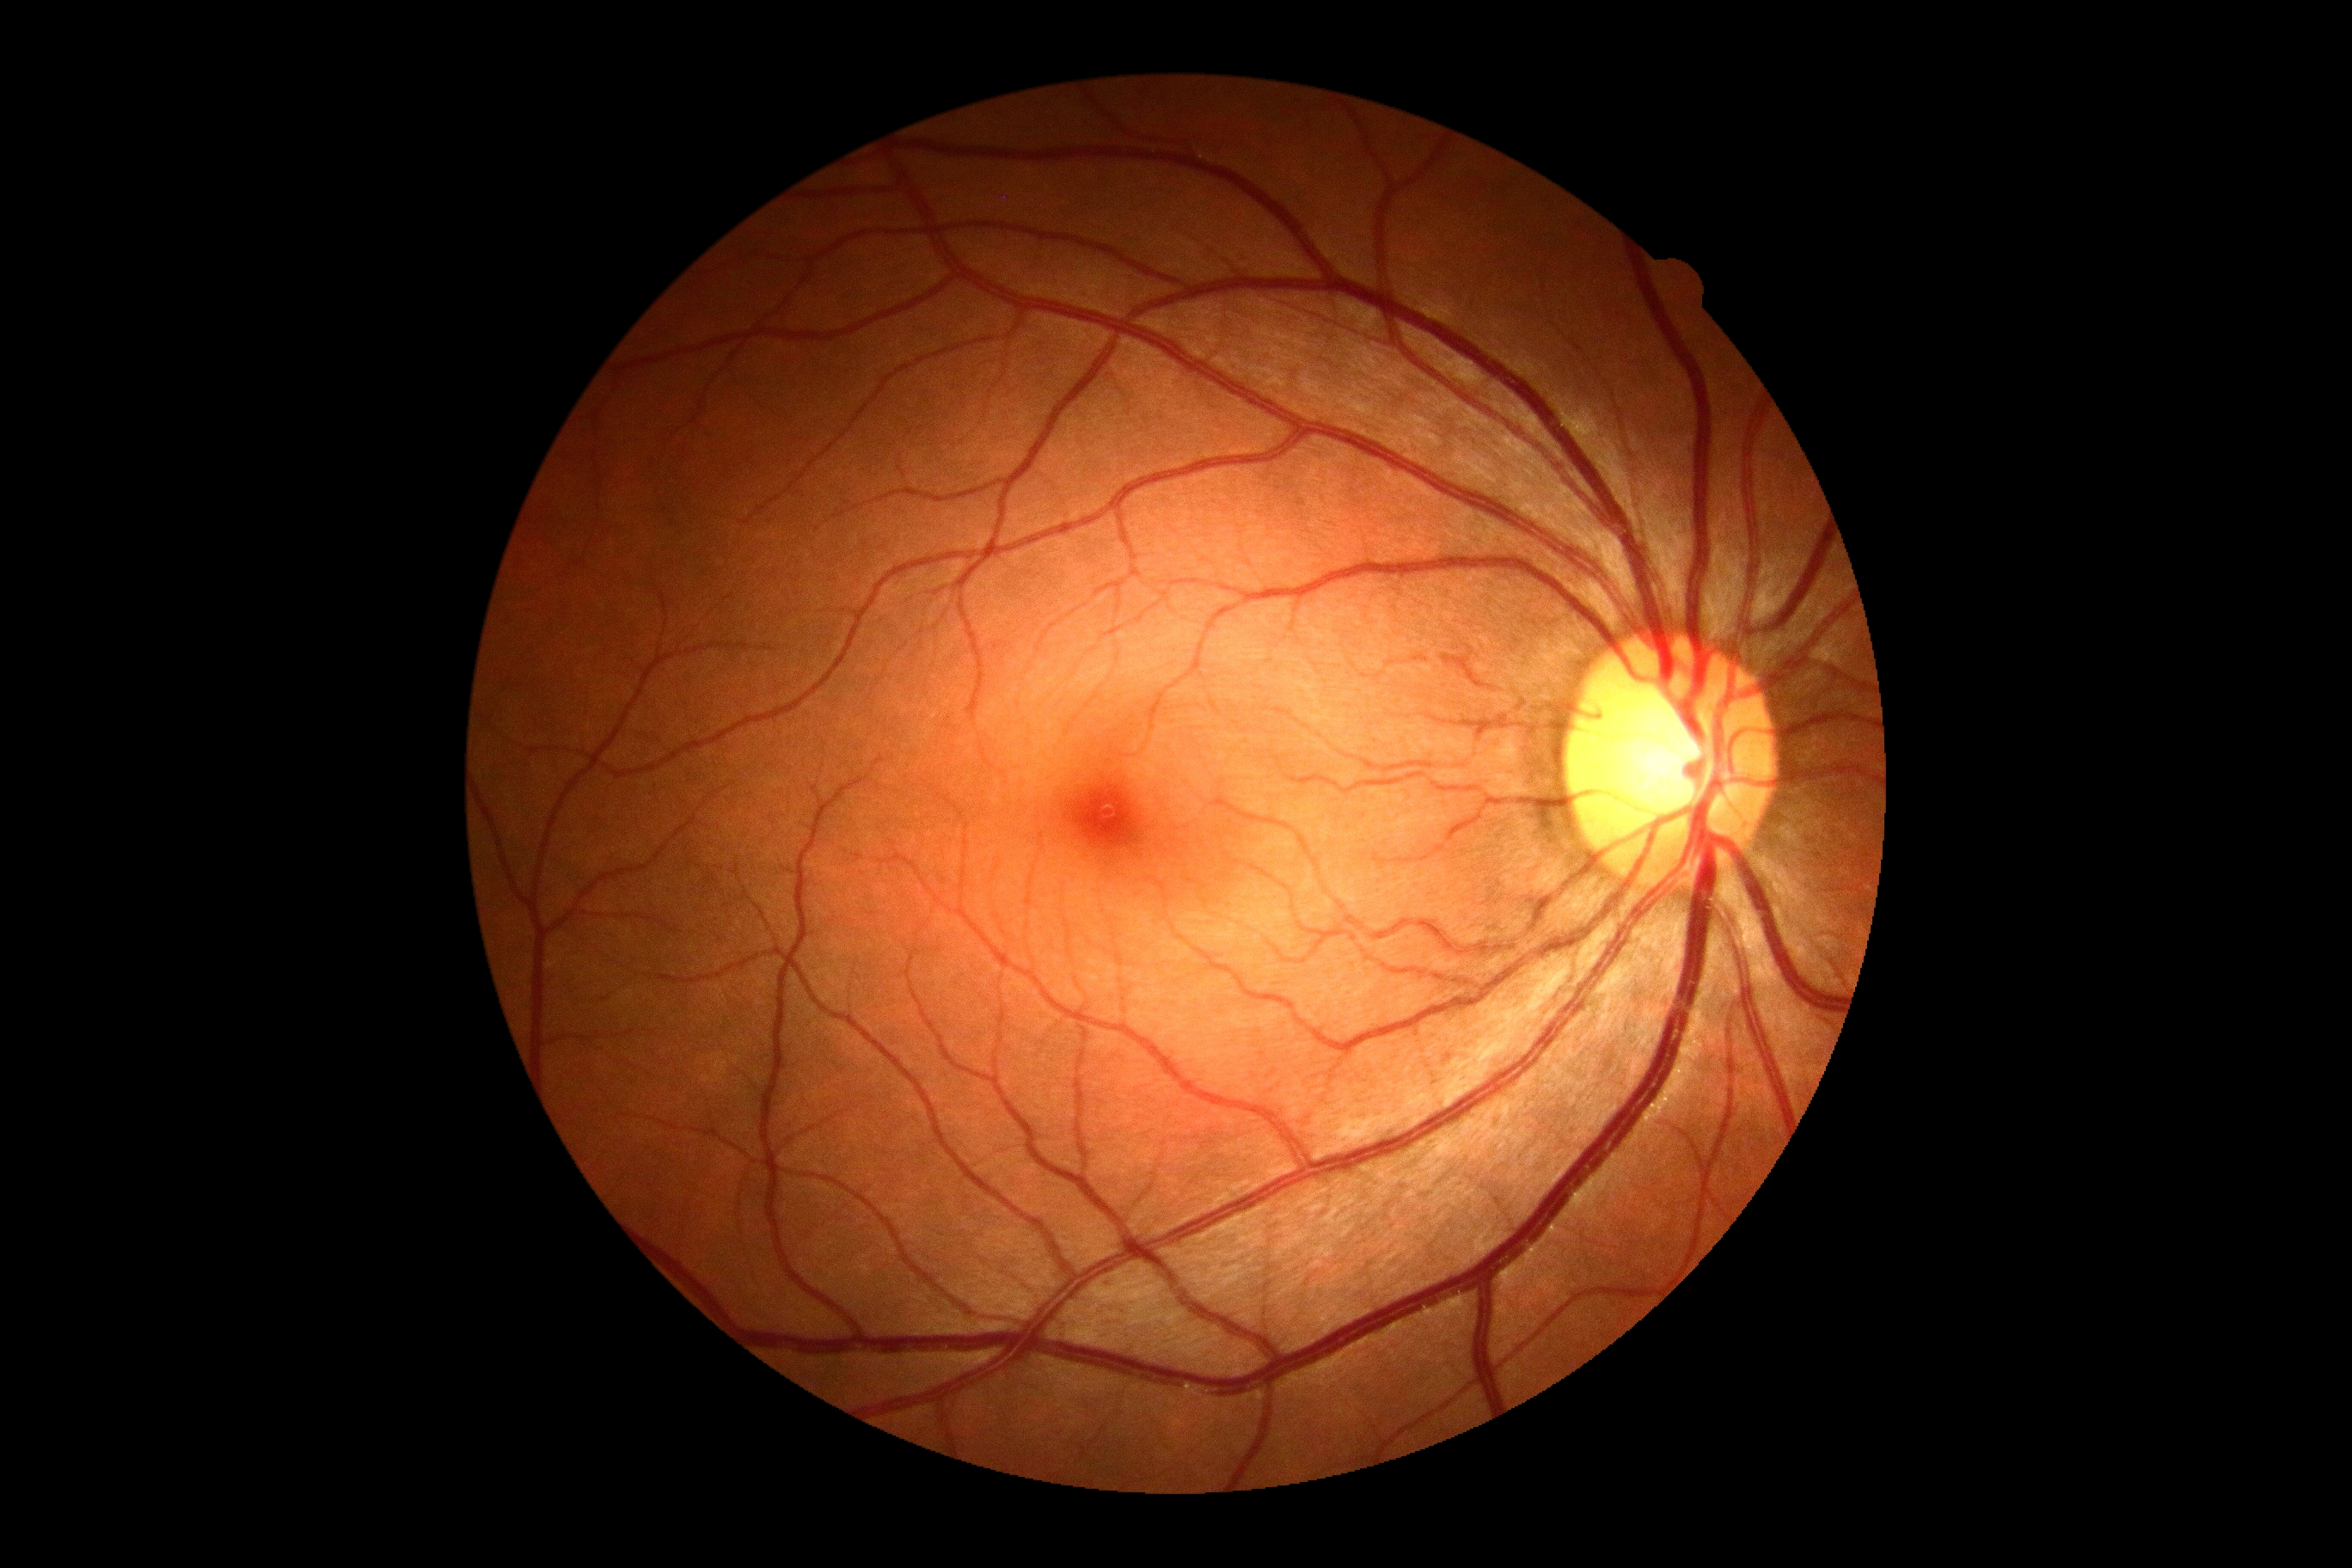
No apparent diabetic retinopathy.
DR severity is no apparent diabetic retinopathy (grade 0).